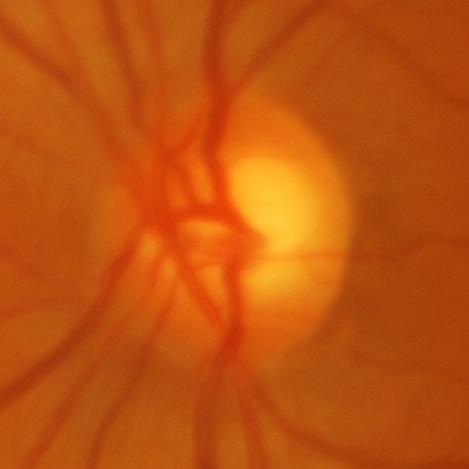

Impression = glaucomatous findings.